Color fundus photograph; 2352 x 1568 pixels.
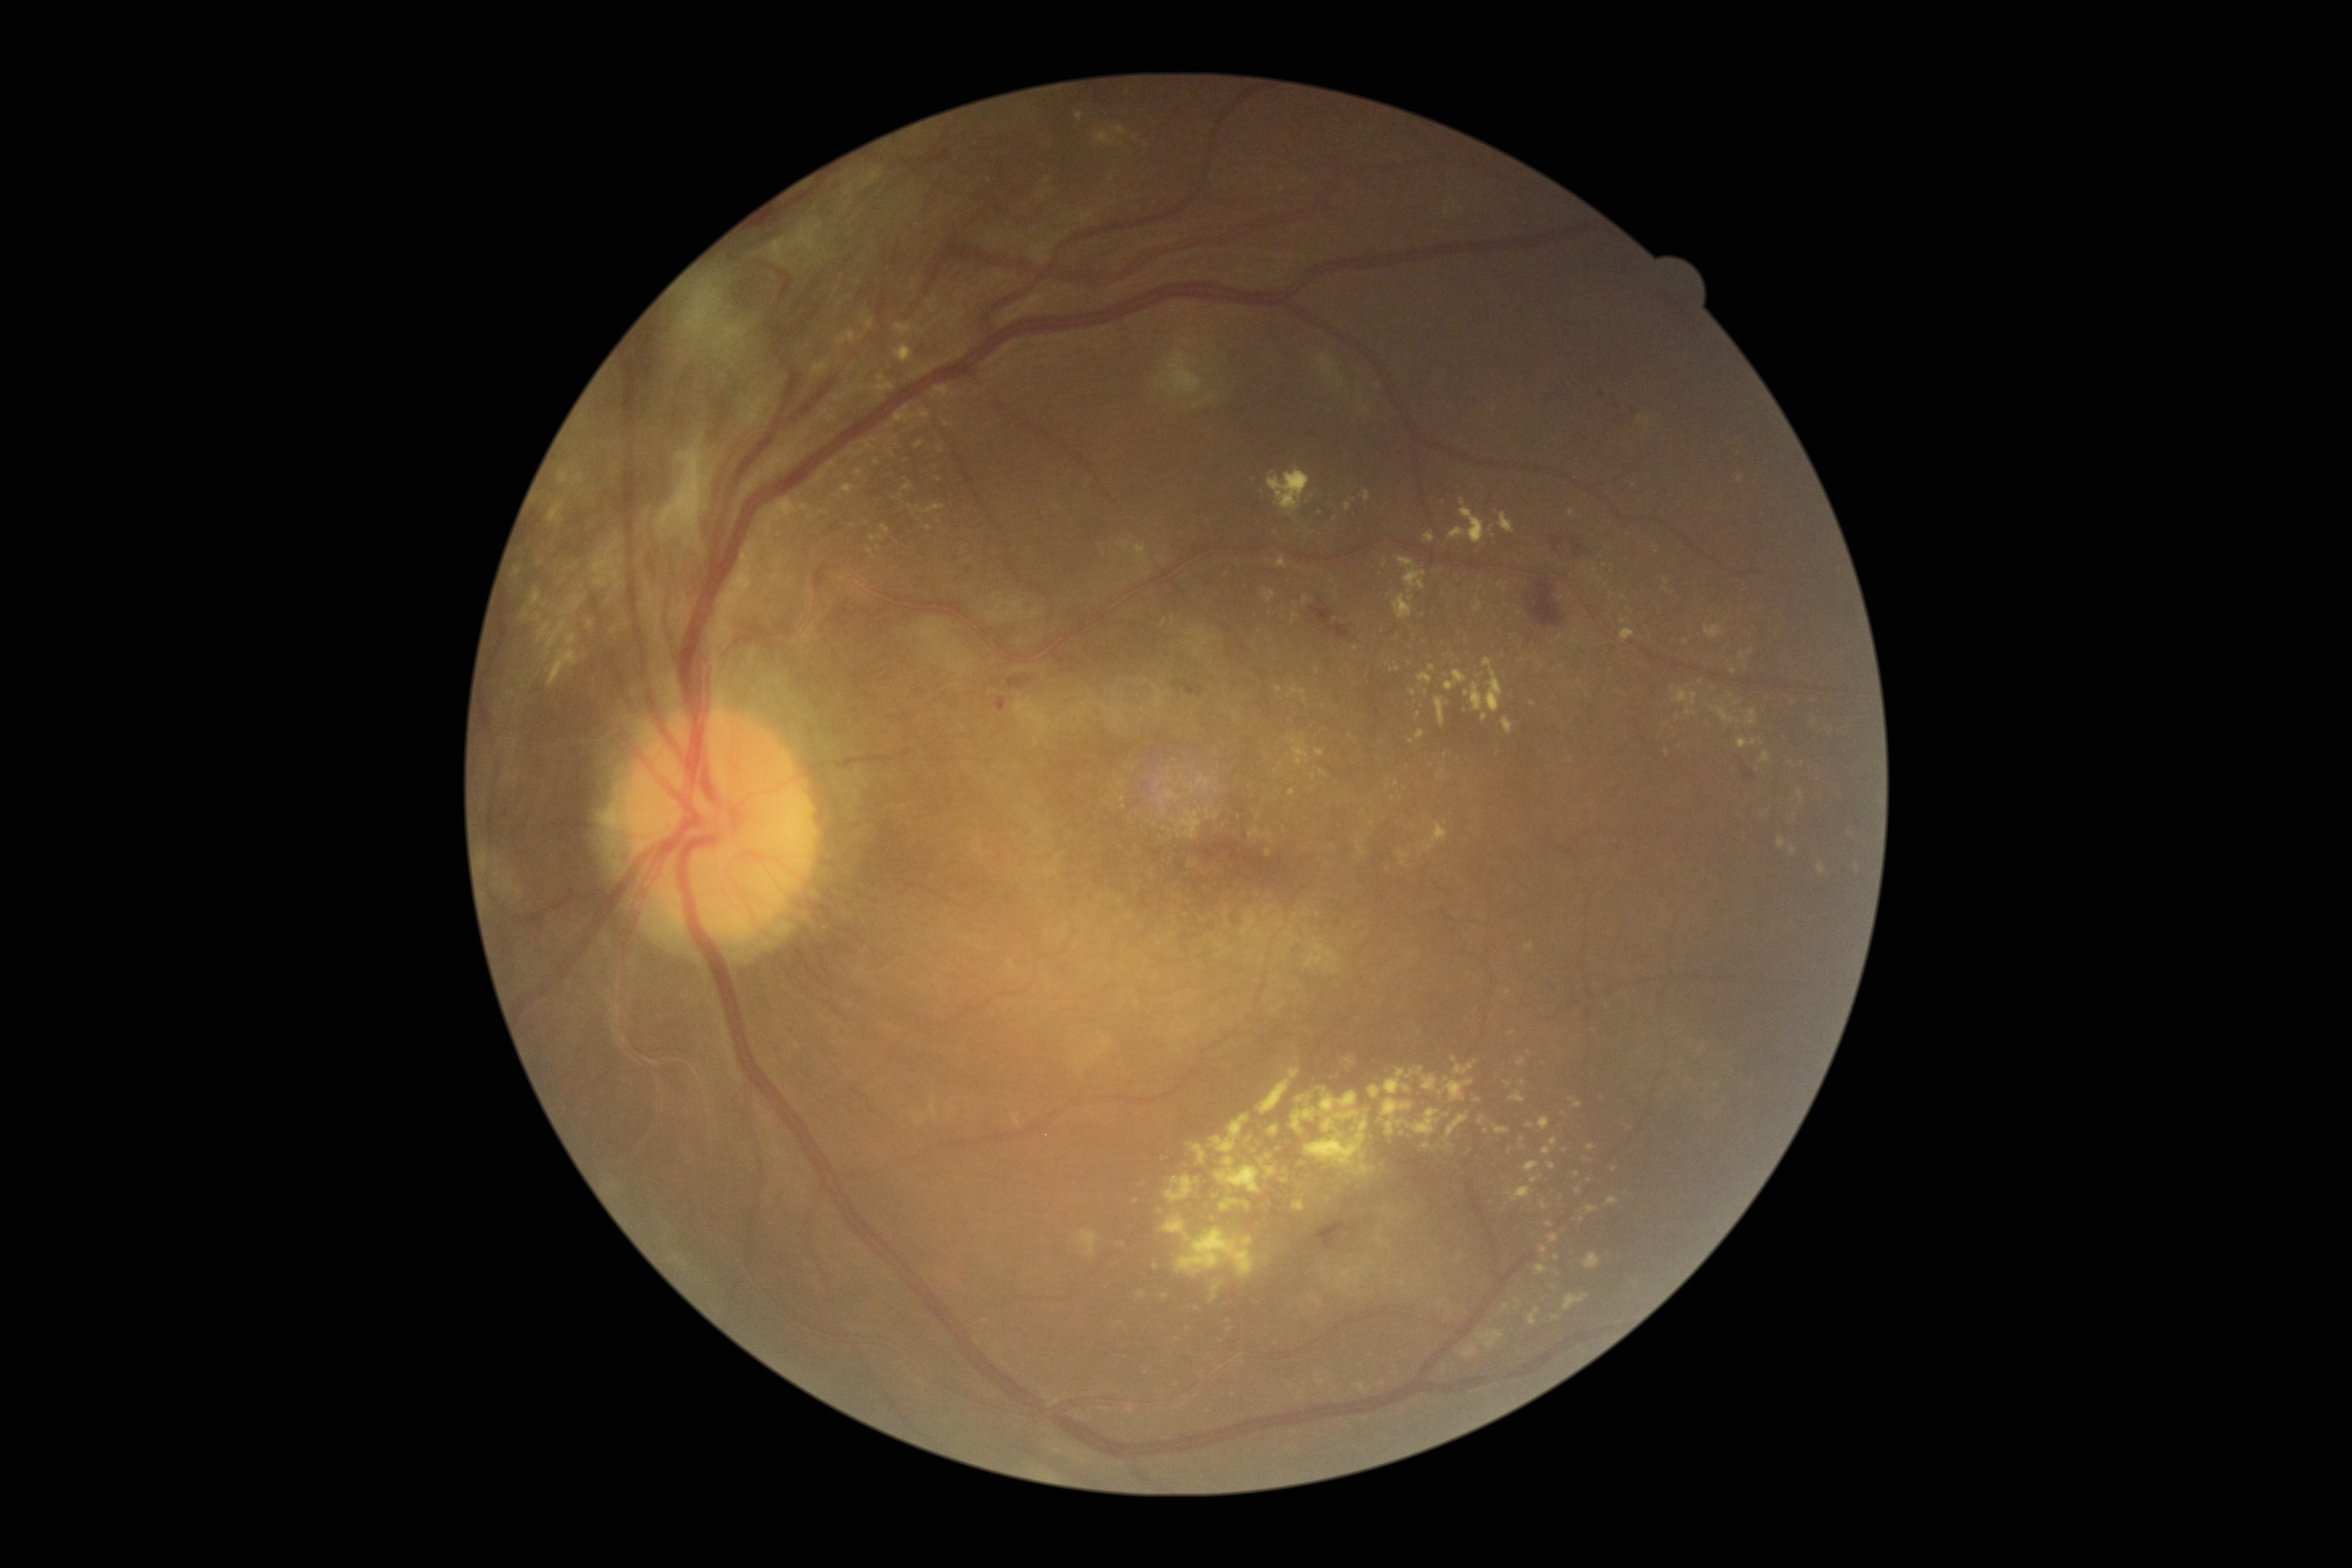 partial: true
dr_grade: 4
dr_grade_name: PDR
lesions:
  ex:
    - <region>1525, 1122, 1534, 1128</region>
    - <region>1449, 499, 1486, 544</region>
    - <region>1335, 1266, 1361, 1295</region>
    - <region>875, 376, 895, 400</region>
    - <region>1531, 1174, 1543, 1183</region>
    - <region>1605, 1196, 1618, 1208</region>
    - <region>1345, 1054, 1356, 1065</region>
    - <region>1319, 769, 1328, 777</region>
    - <region>531, 587, 541, 607</region>
    - <region>887, 449, 896, 457</region>
    - <region>1583, 1252, 1601, 1269</region>
  ex_small_approx:
    - 1354, 1129
    - 1532, 703
    - 1328, 1378
    - 1505, 589
    - 900, 496
    - 1279, 690
    - 1246, 1205
    - 889, 426